2102x1736: 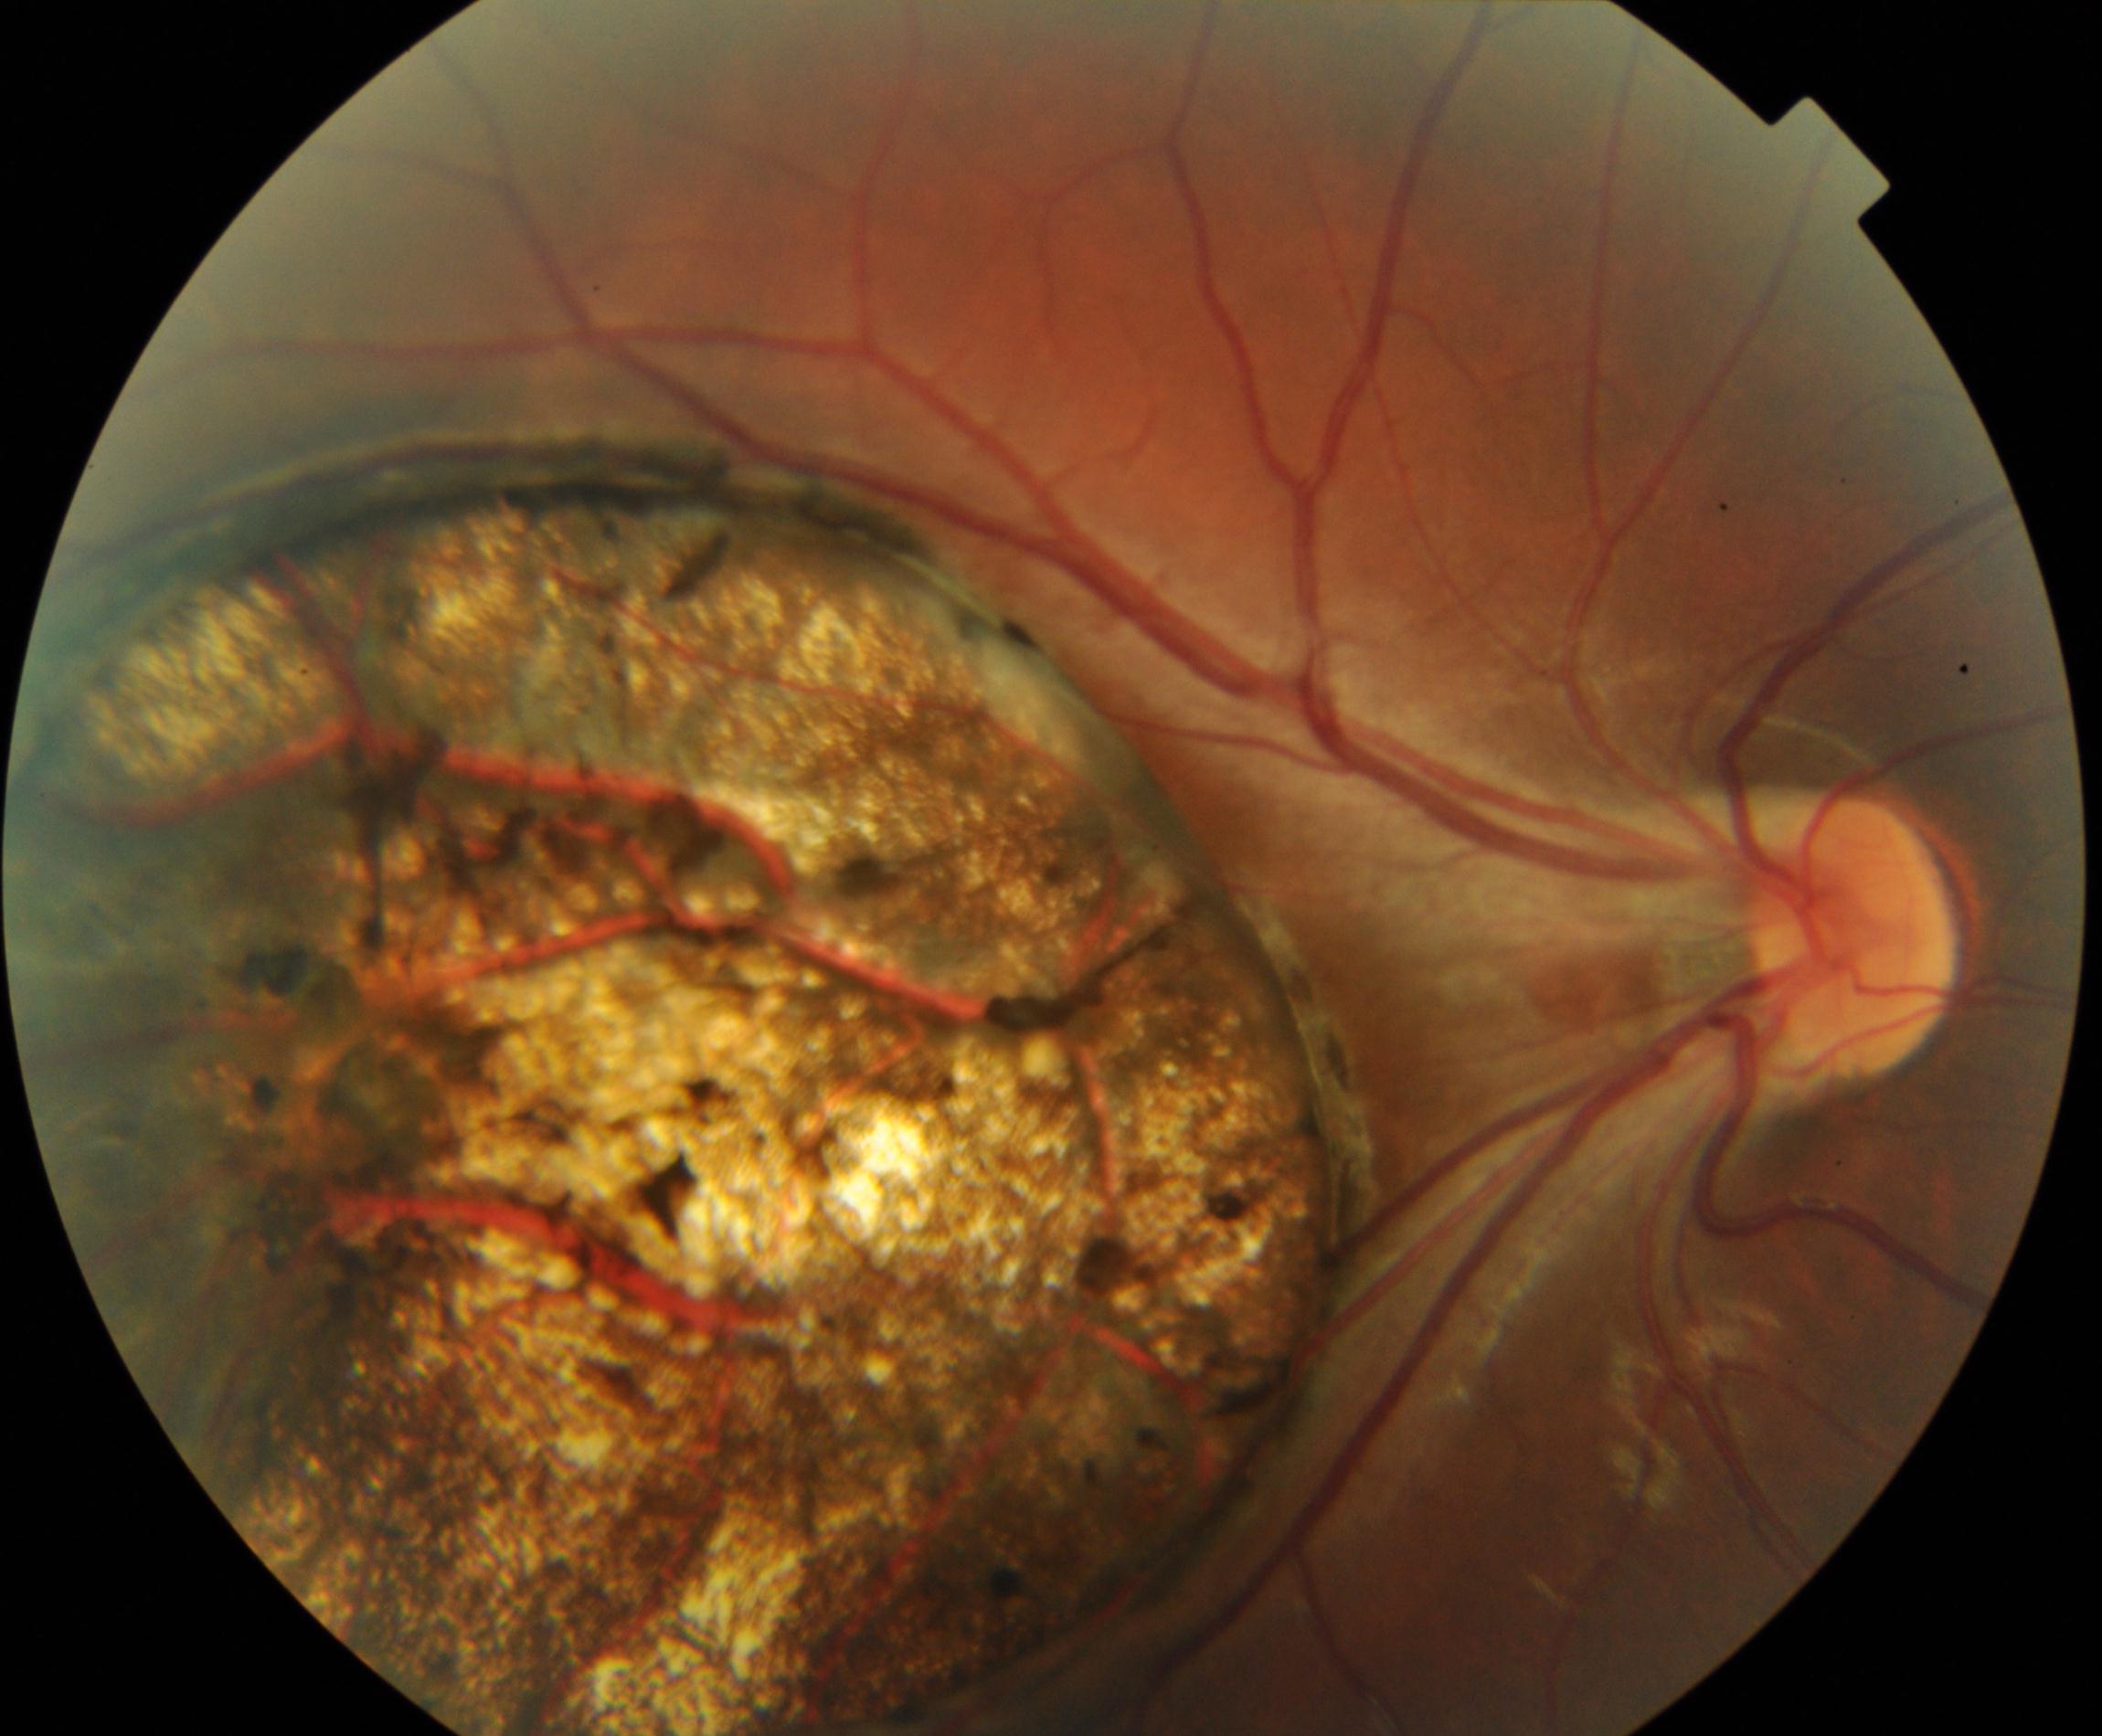
Findings: chorioretinal atrophy or coloboma.